Phoenix ICON wide-field infant fundus image. Captured with the Phoenix ICON (100° field of view): 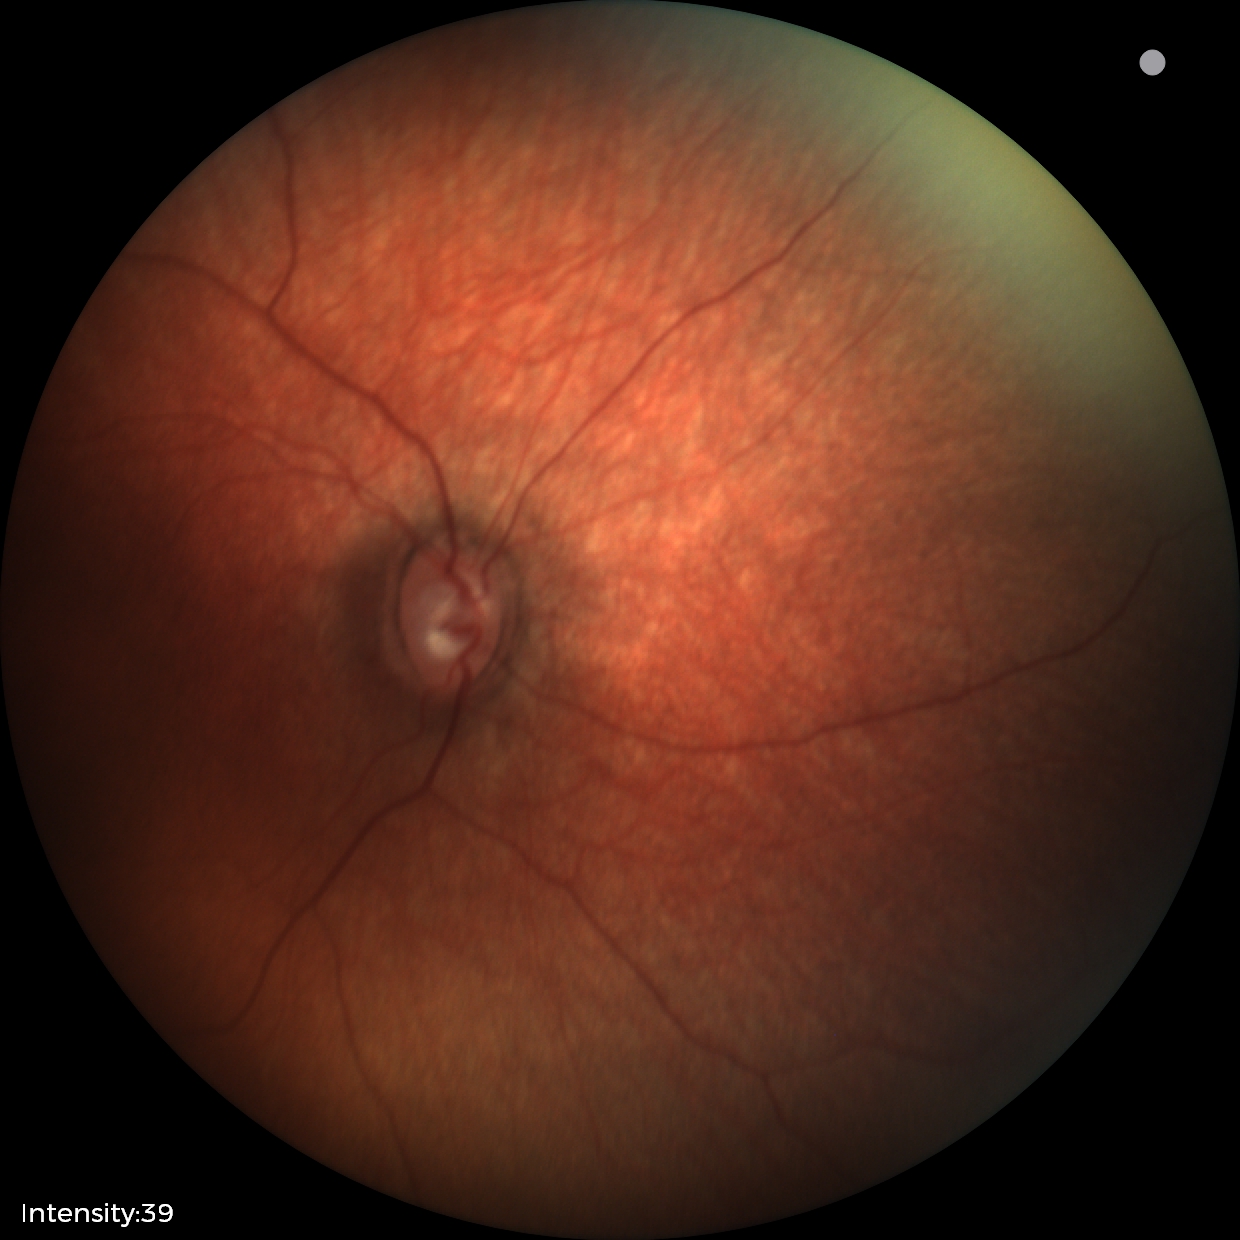

Impression: physiological retinal finding.